Graded on the modified Davis scale.
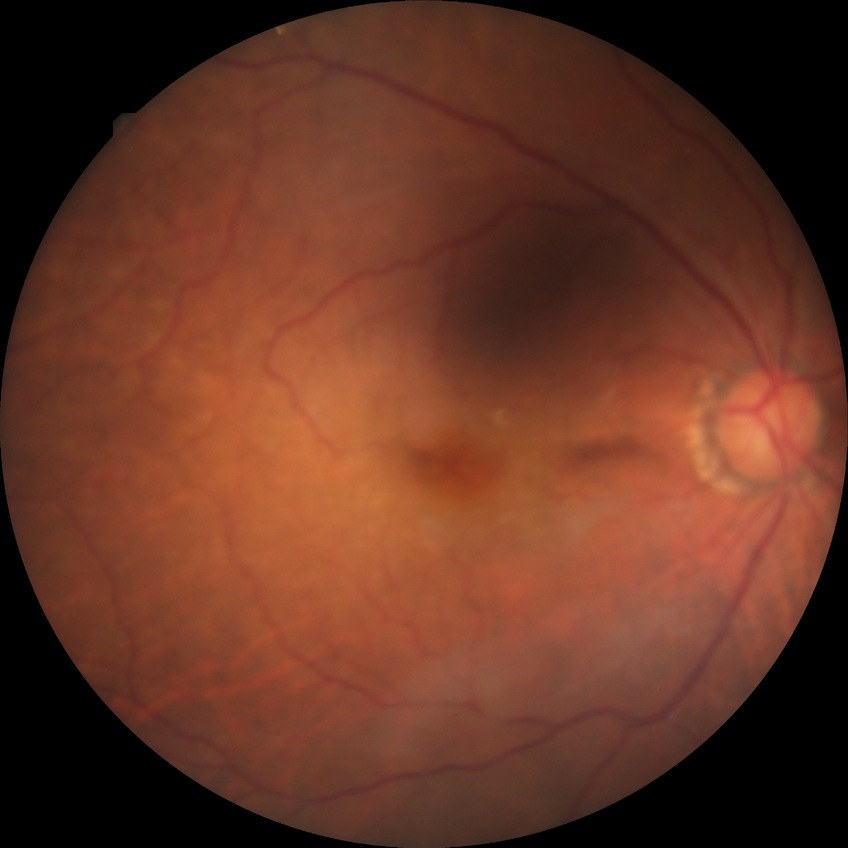

DR is NDR.